Wide-field fundus photograph from neonatal ROP screening — 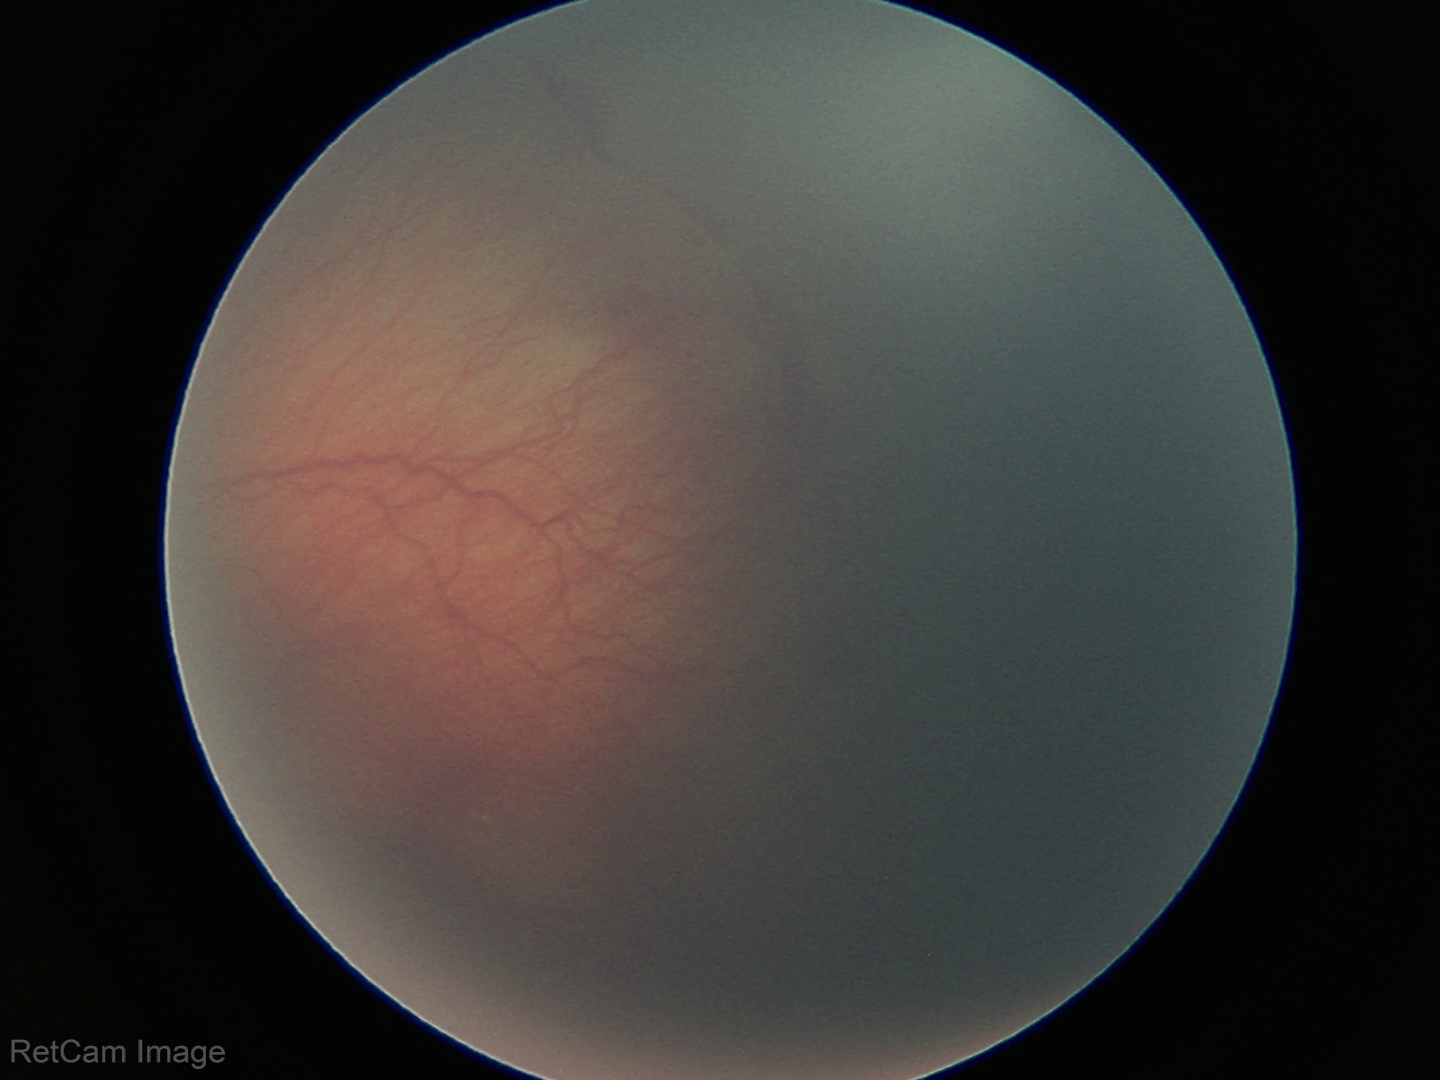

Examination diagnosed as ROP stage 2.
Without plus disease.